Optic disc region of a color fundus photo: 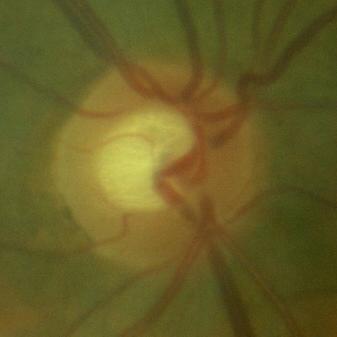
Q: Glaucoma assessment?
A: No — no signs of glaucoma.